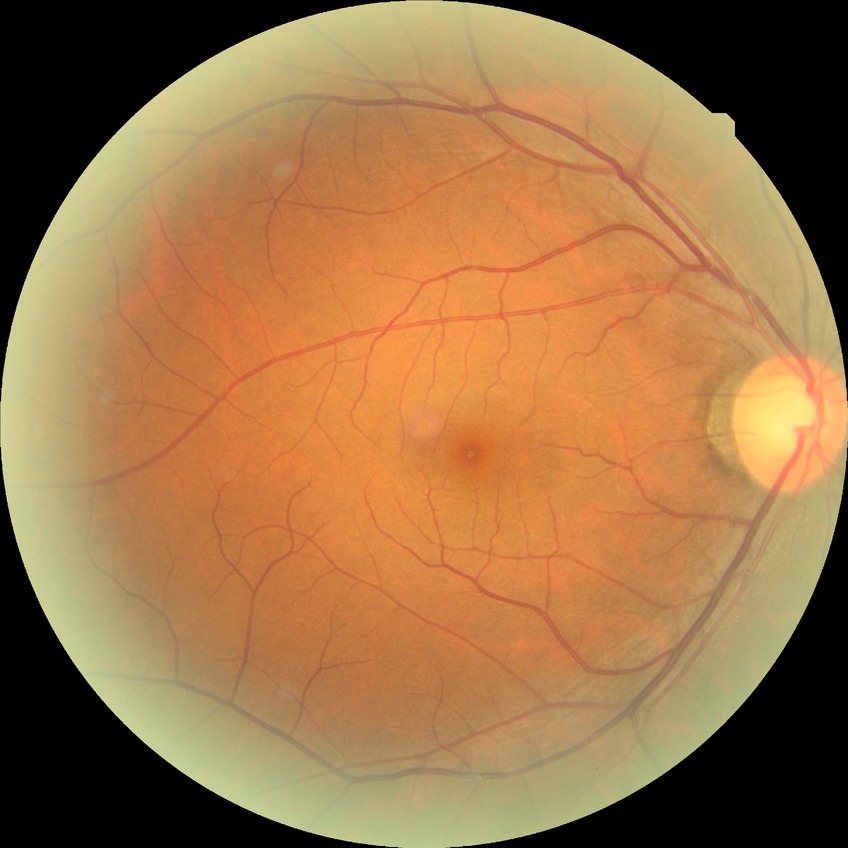
Assessment:
• Davis stage: NDR